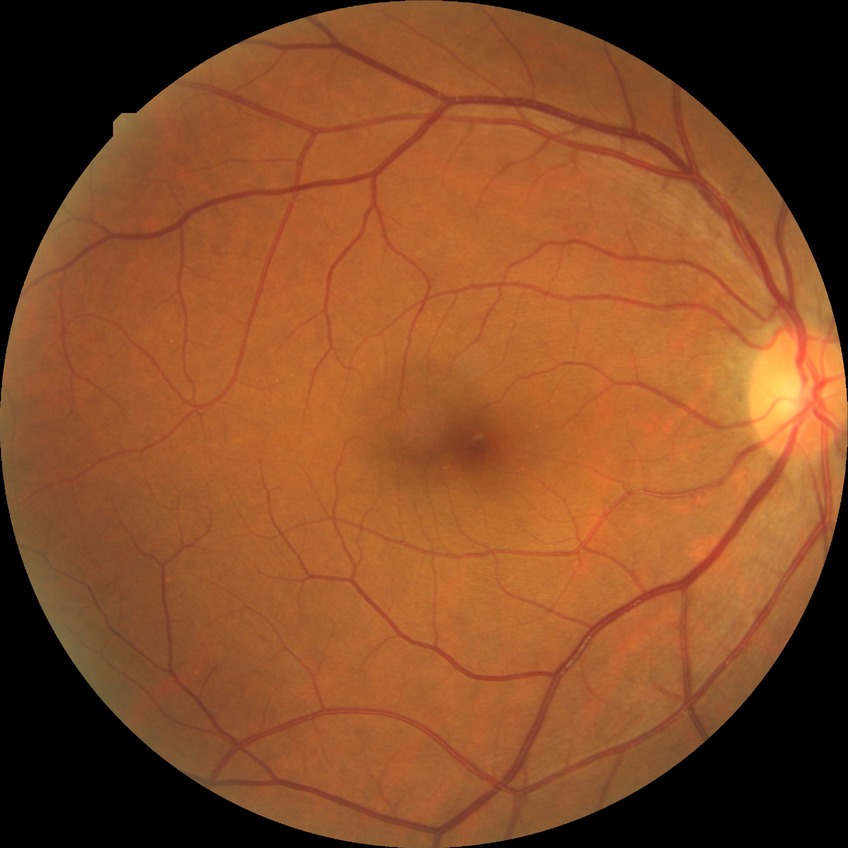
diabetic retinopathy (DR) = no diabetic retinopathy (NDR)